FOV: 45 degrees: 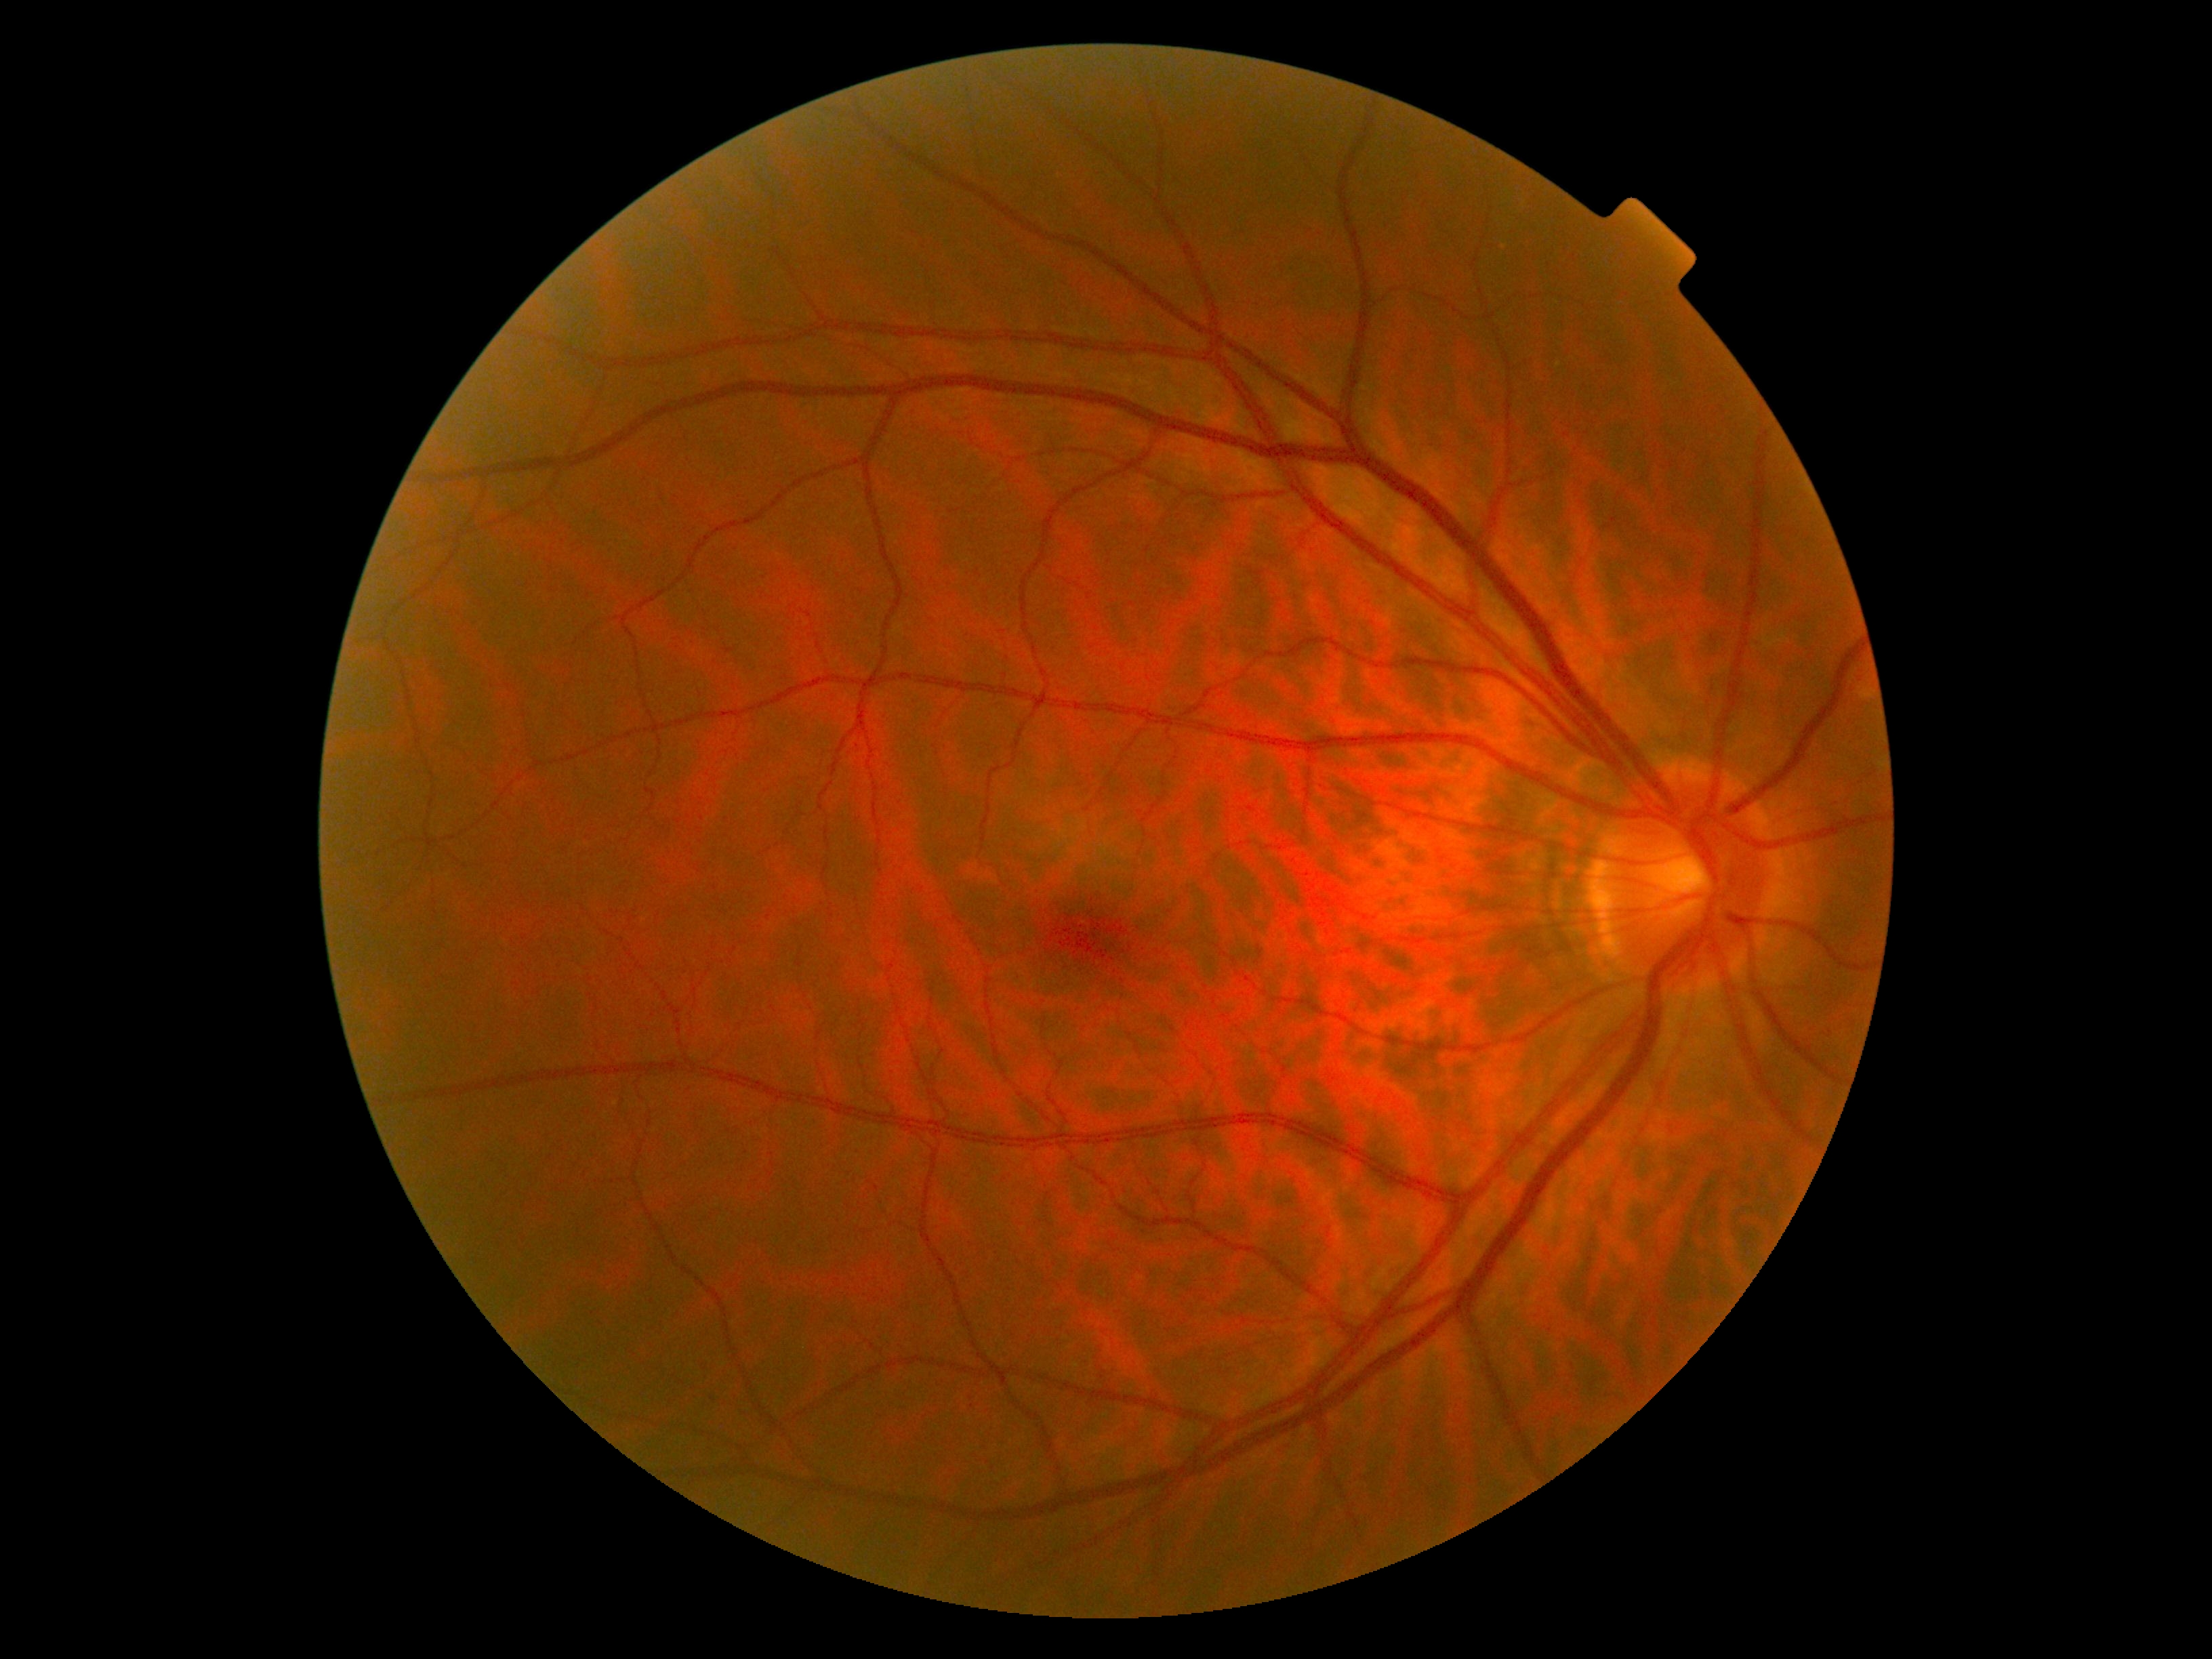 dr_grade: 0